2228x1652
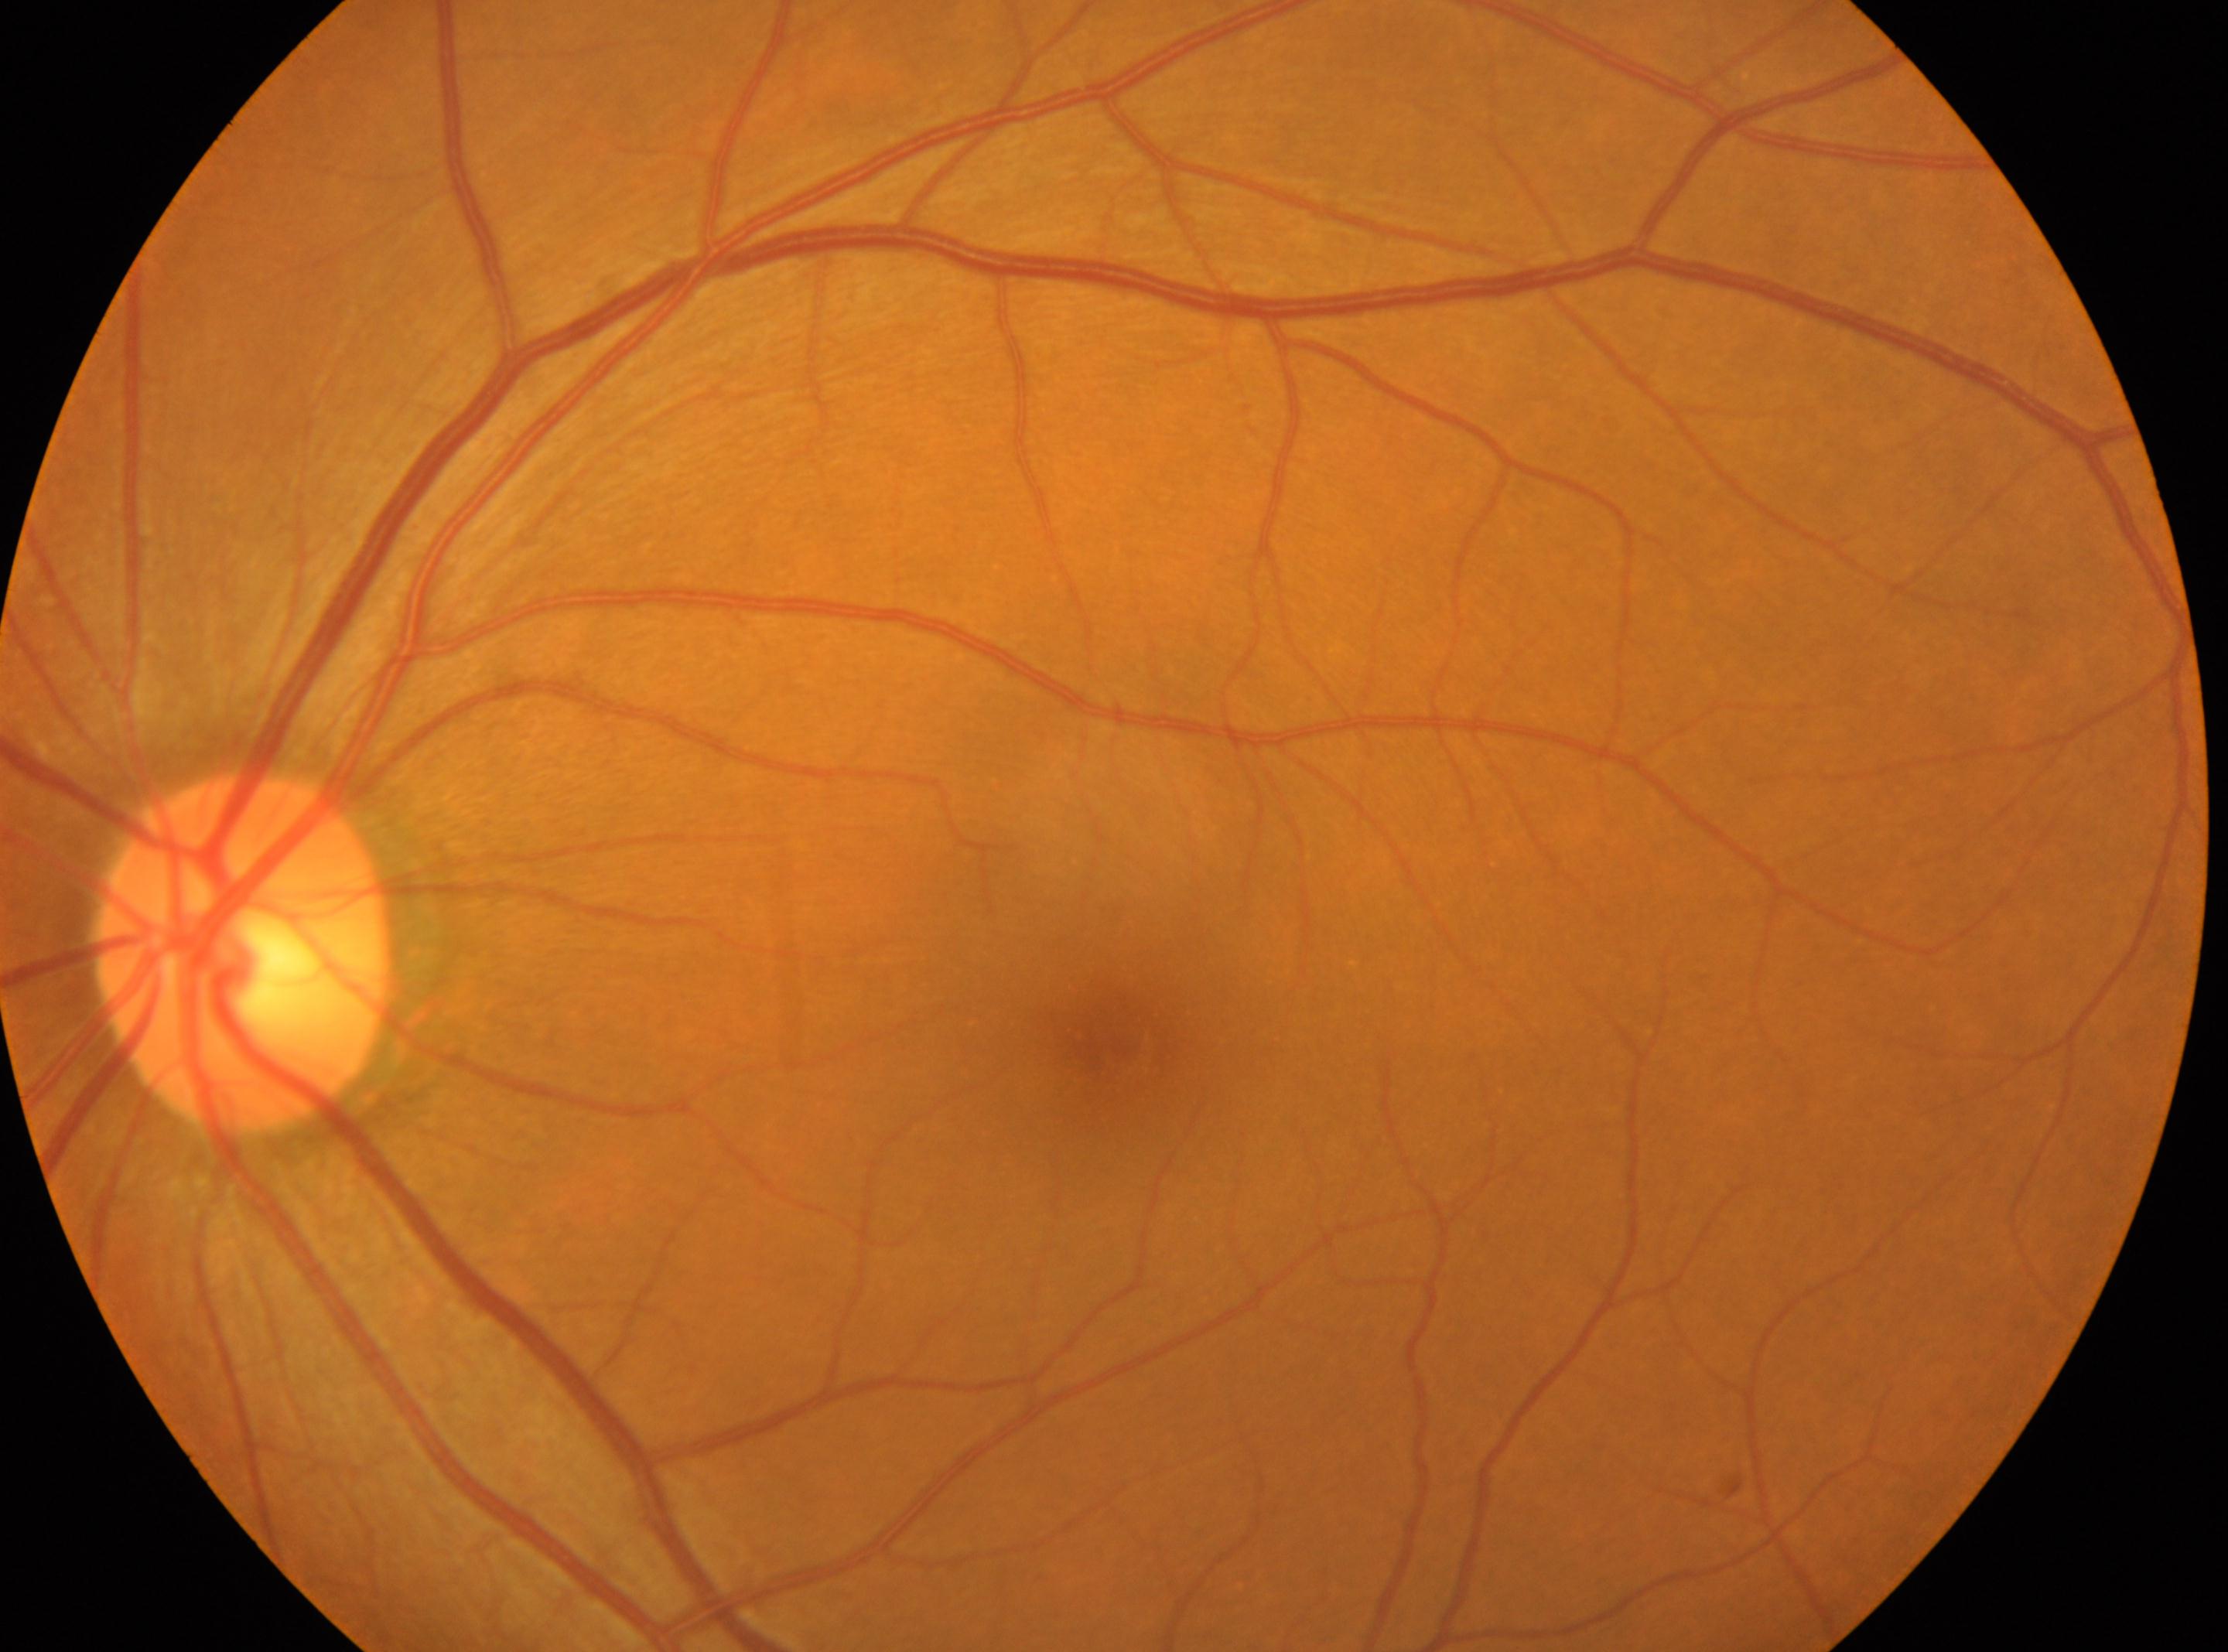

Fovea centralis: 1112, 1032.
ONH: 244, 953.
DR severity is grade 0.
This is the oculus sinister.